Handheld portable fundus camera image; 60° FOV; 2212 by 1659 pixels
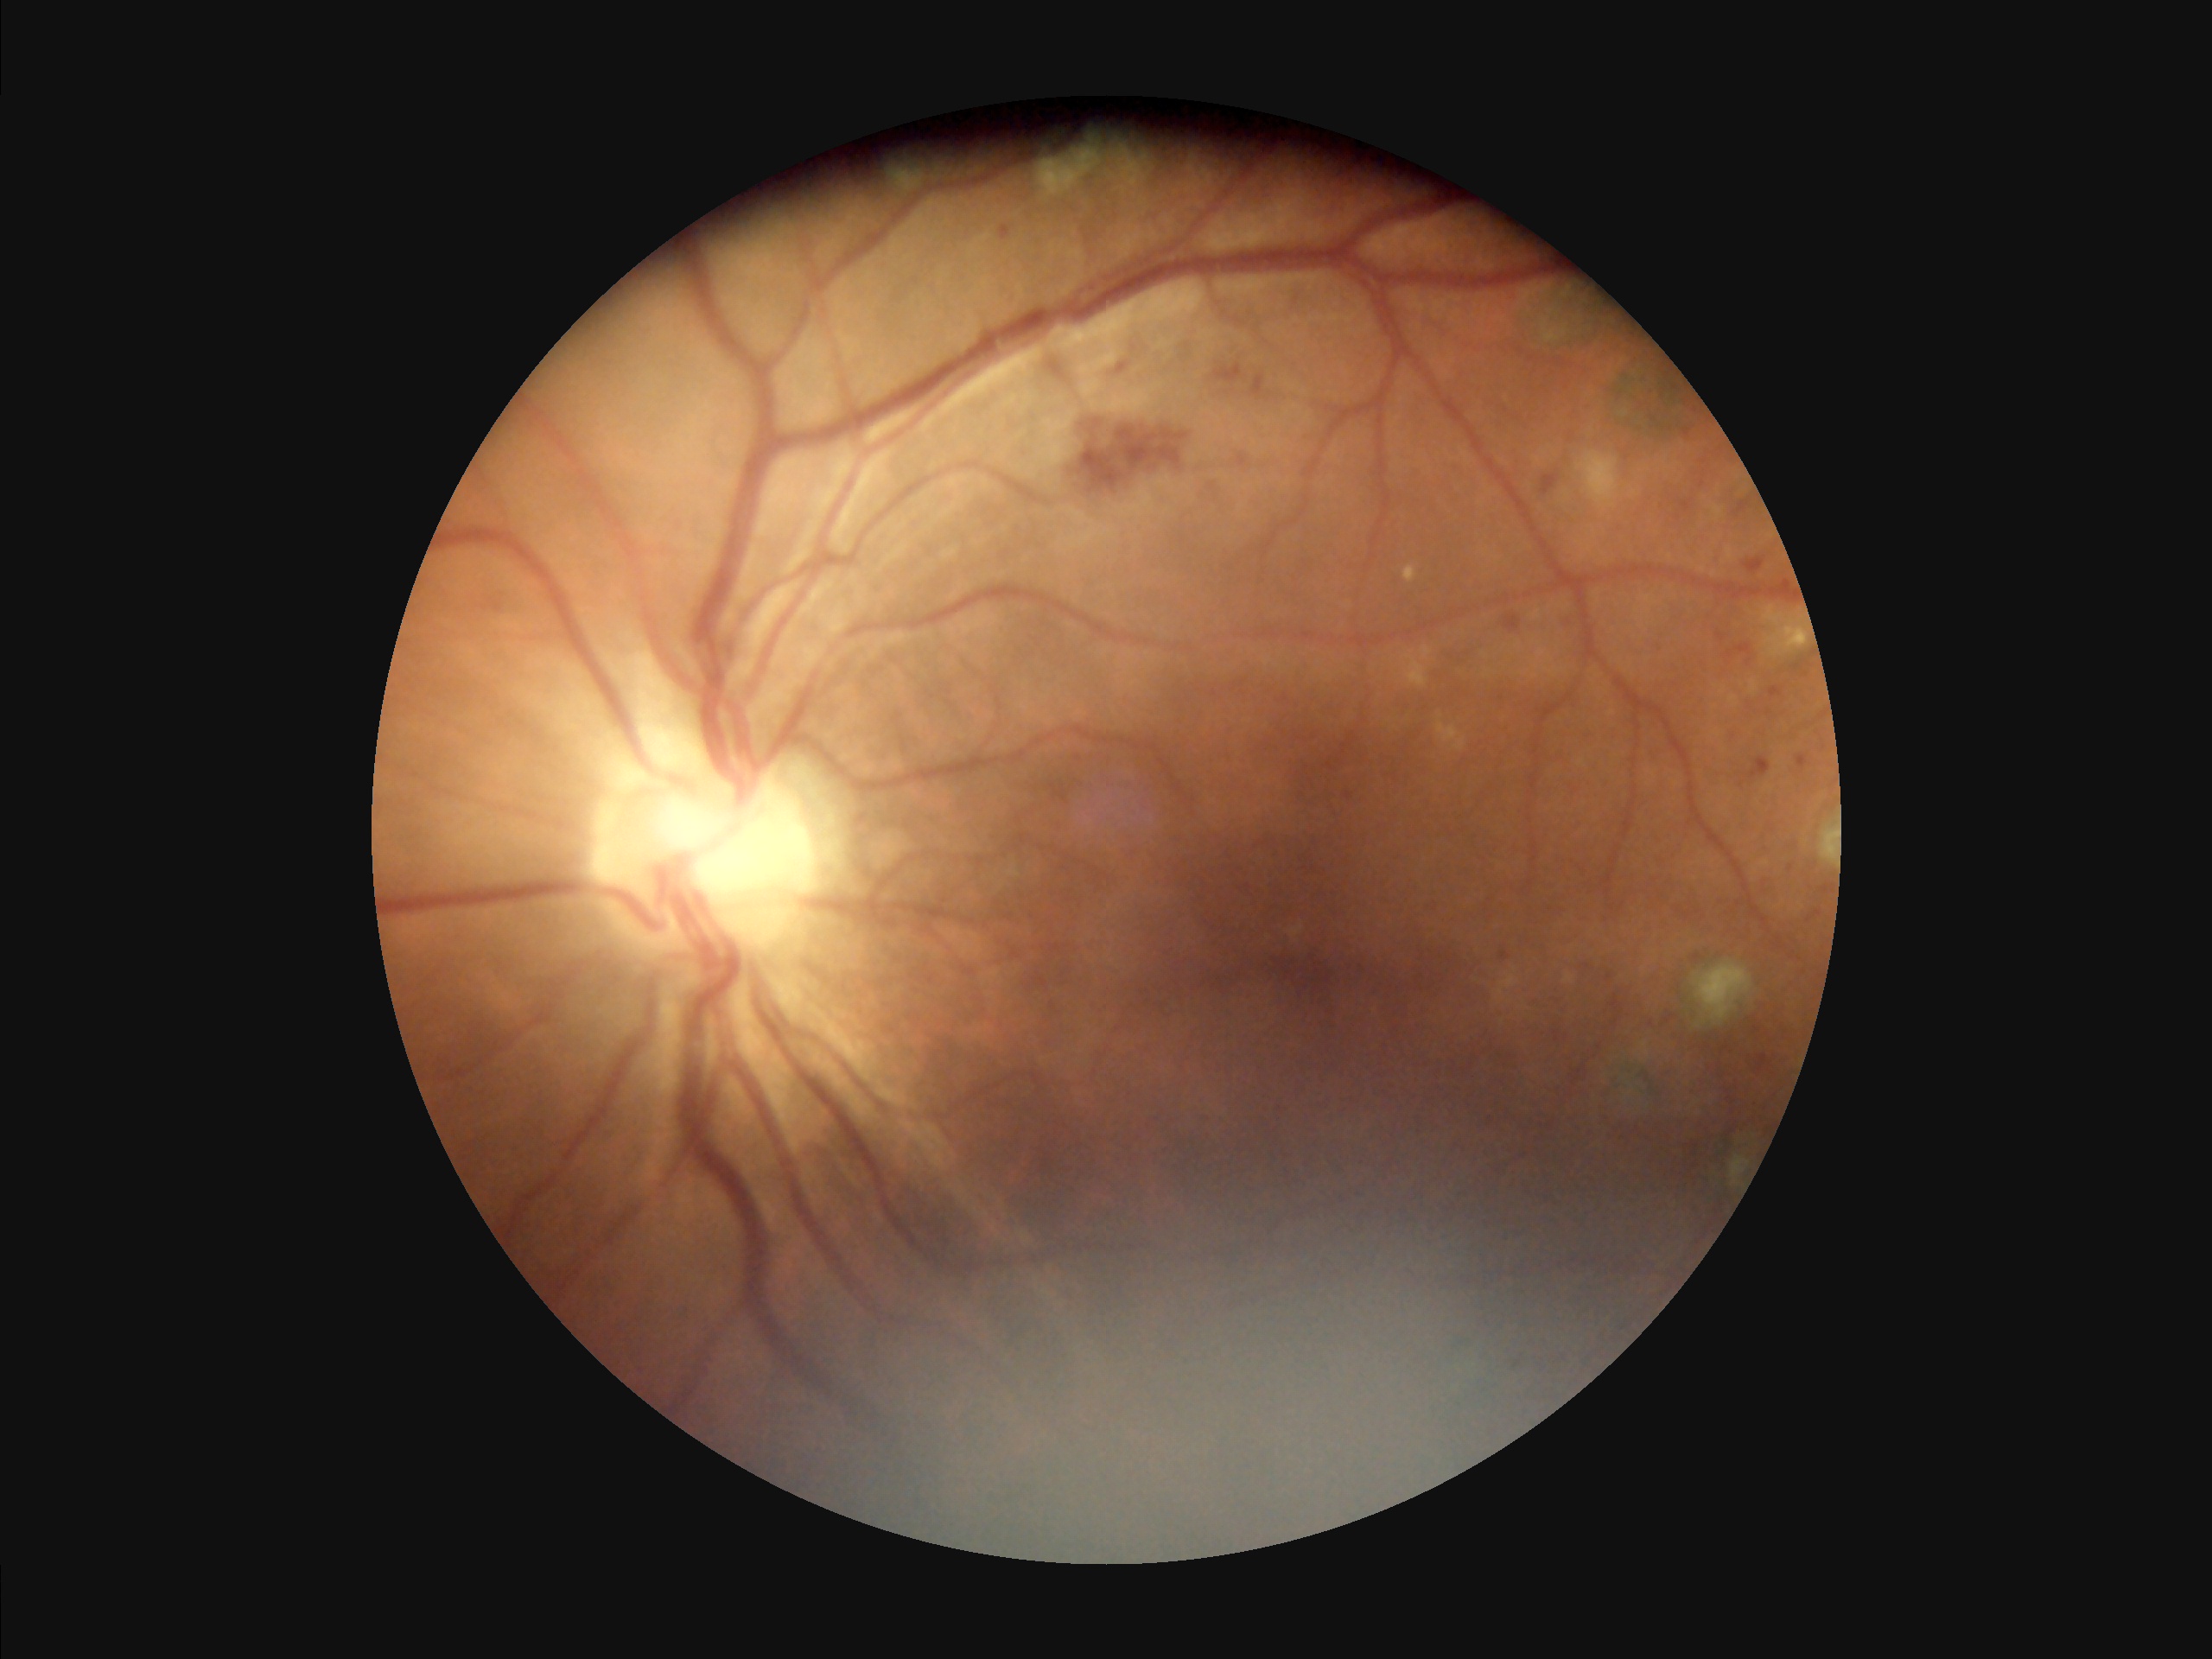

Image quality assessment:
- overall: low
- contrast: good
- illumination/color: suboptimal
- clarity: out of focus